Nonmydriatic · color fundus image
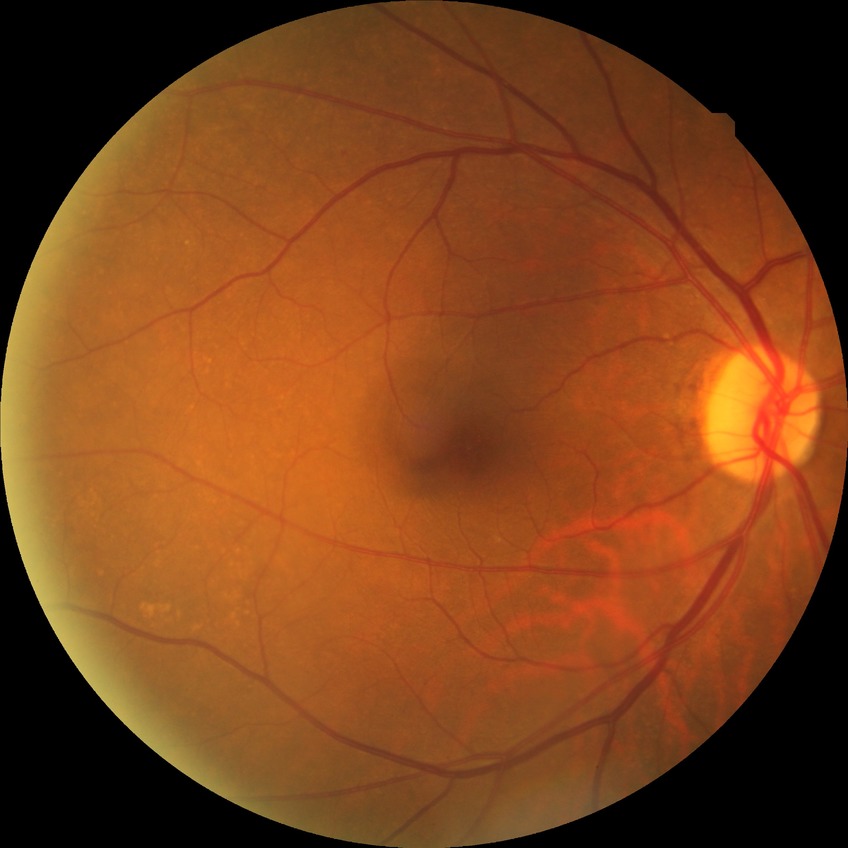
  davis_grade: no diabetic retinopathy (NDR)